640x480. Wide-field contact fundus photograph of an infant.
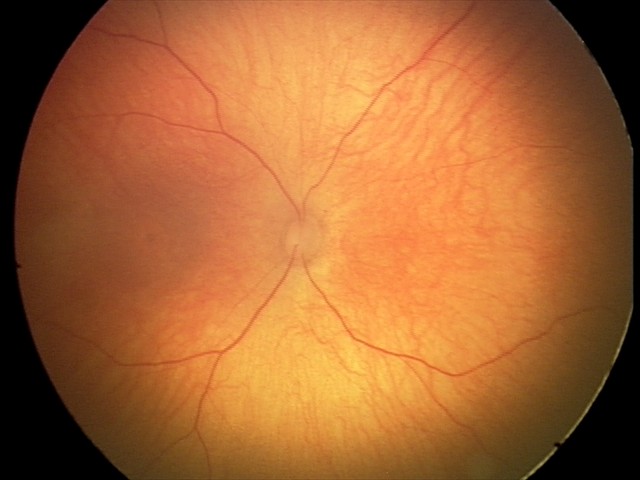 Screening: optic nerve hypoplasia.